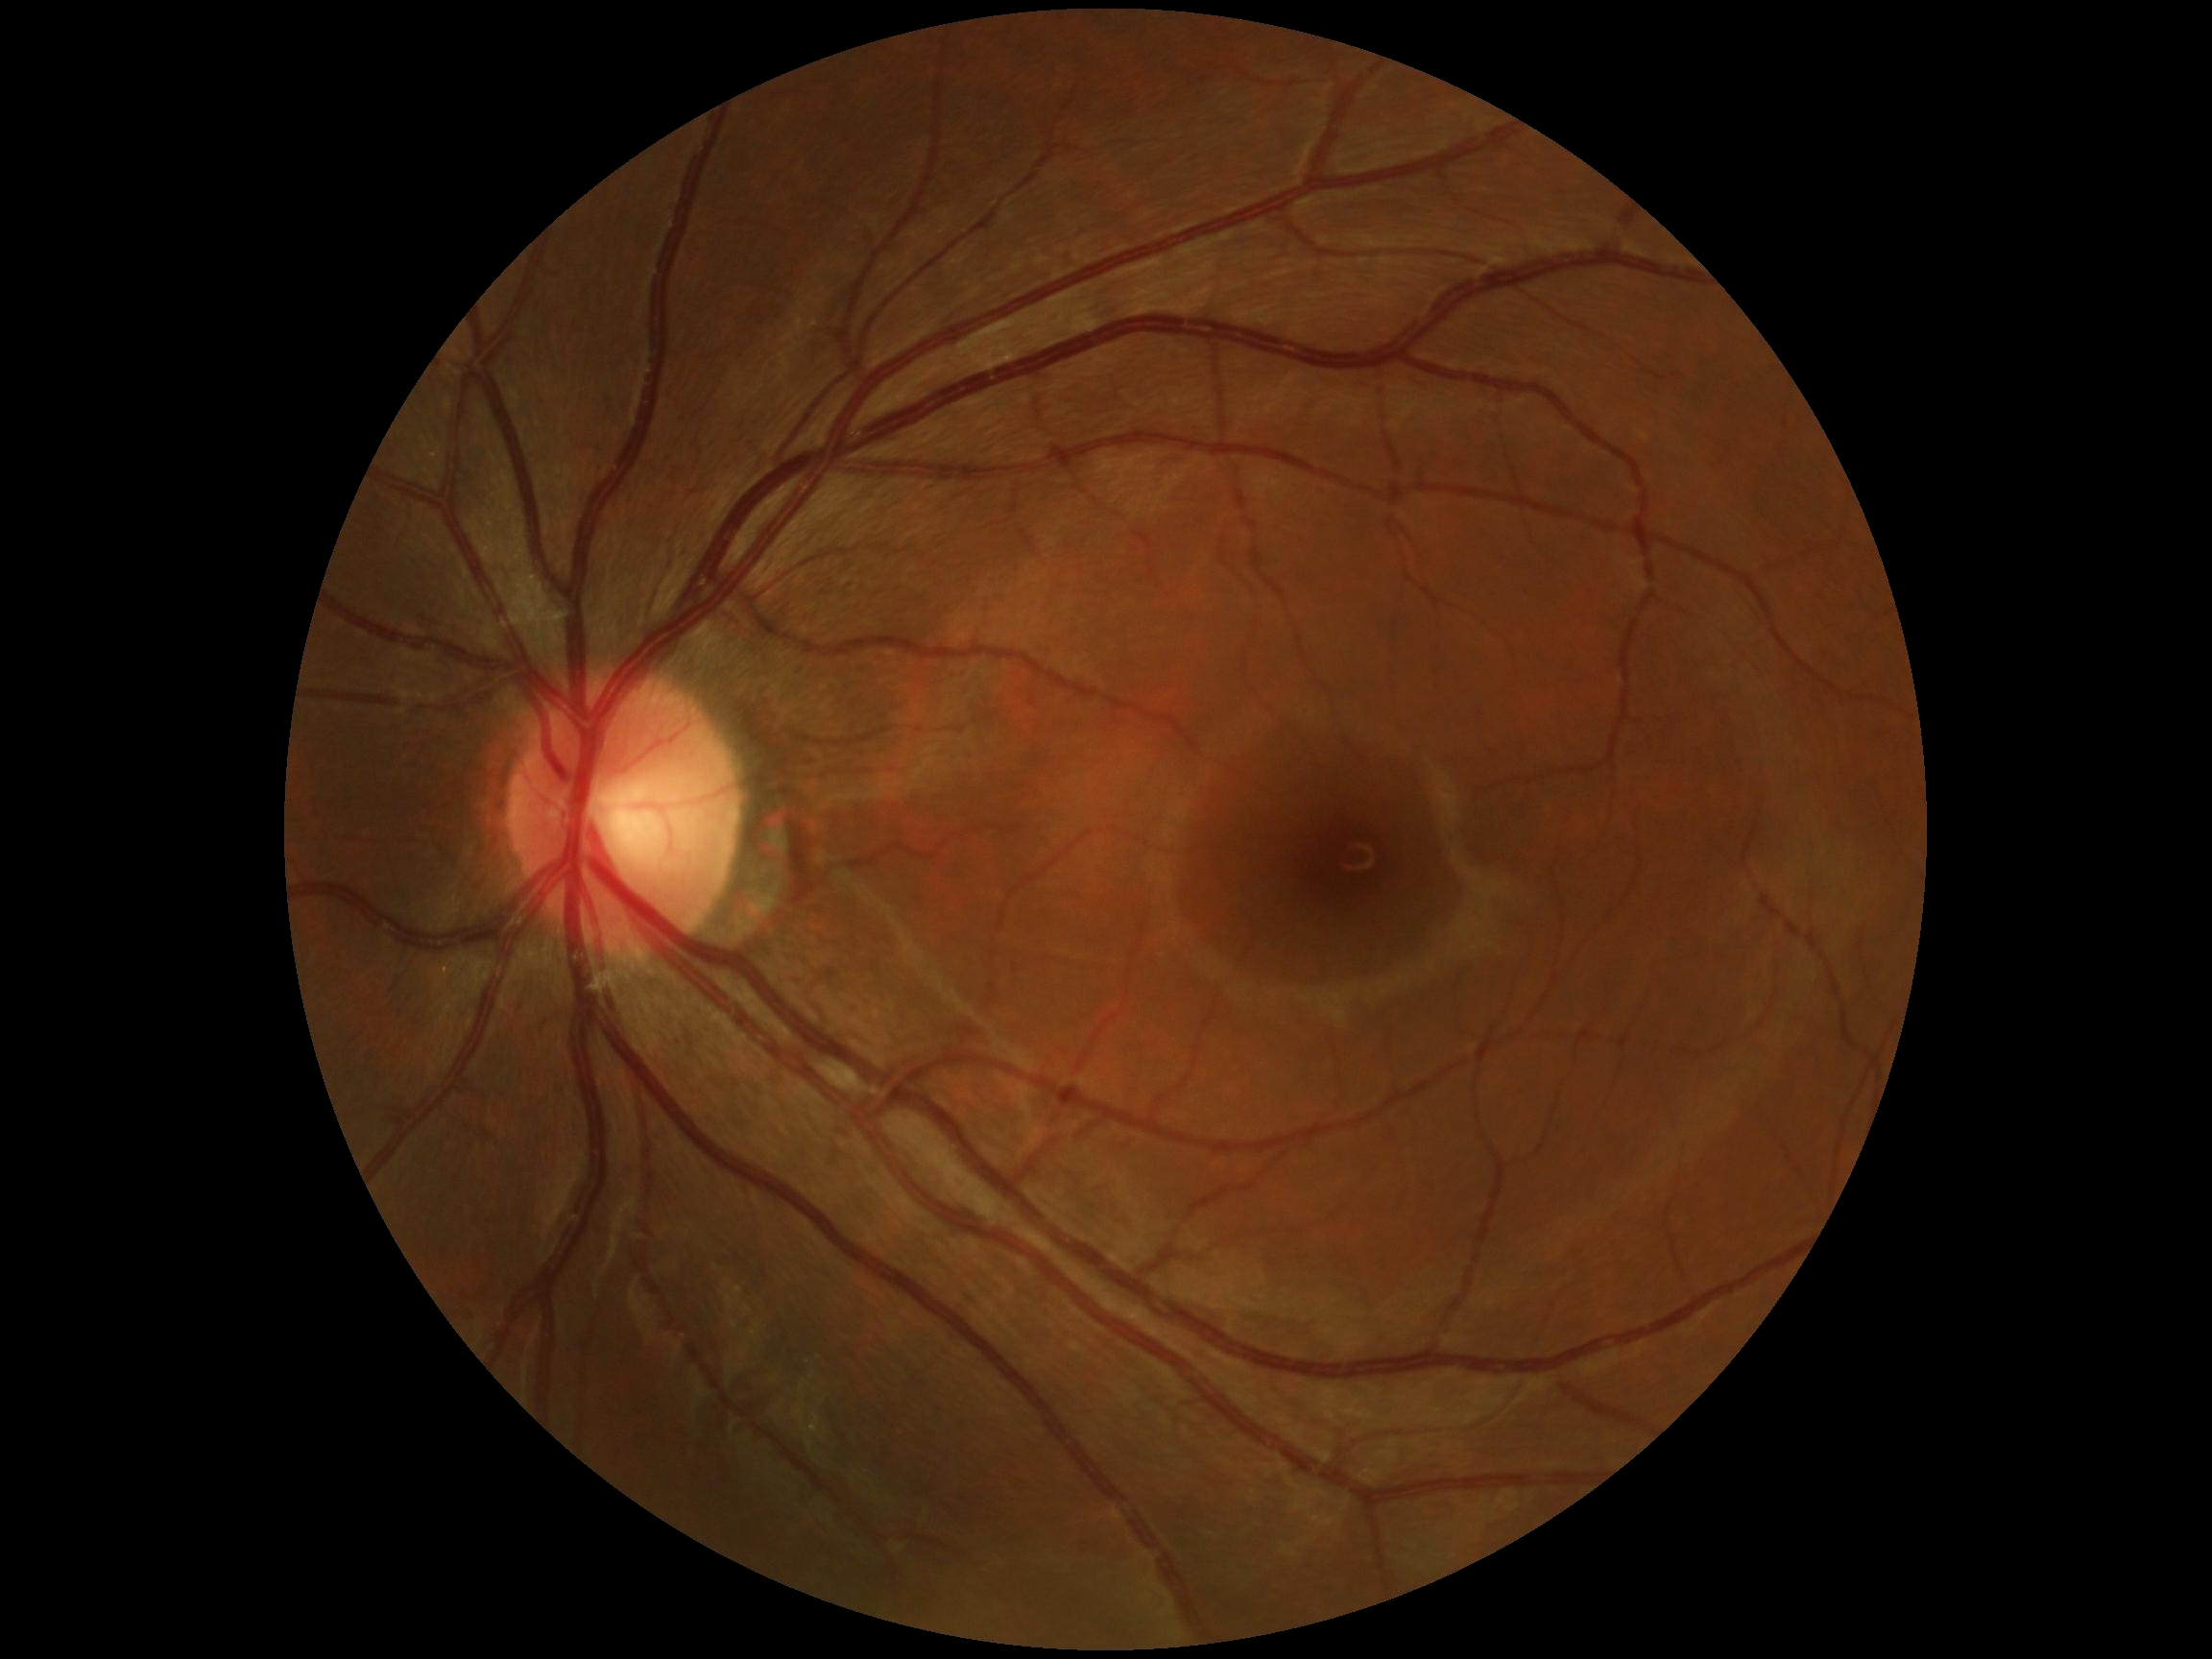 diabetic retinopathy (DR) = grade 0.